Phoenix ICON, 100° FOV. Pediatric wide-field fundus photograph — 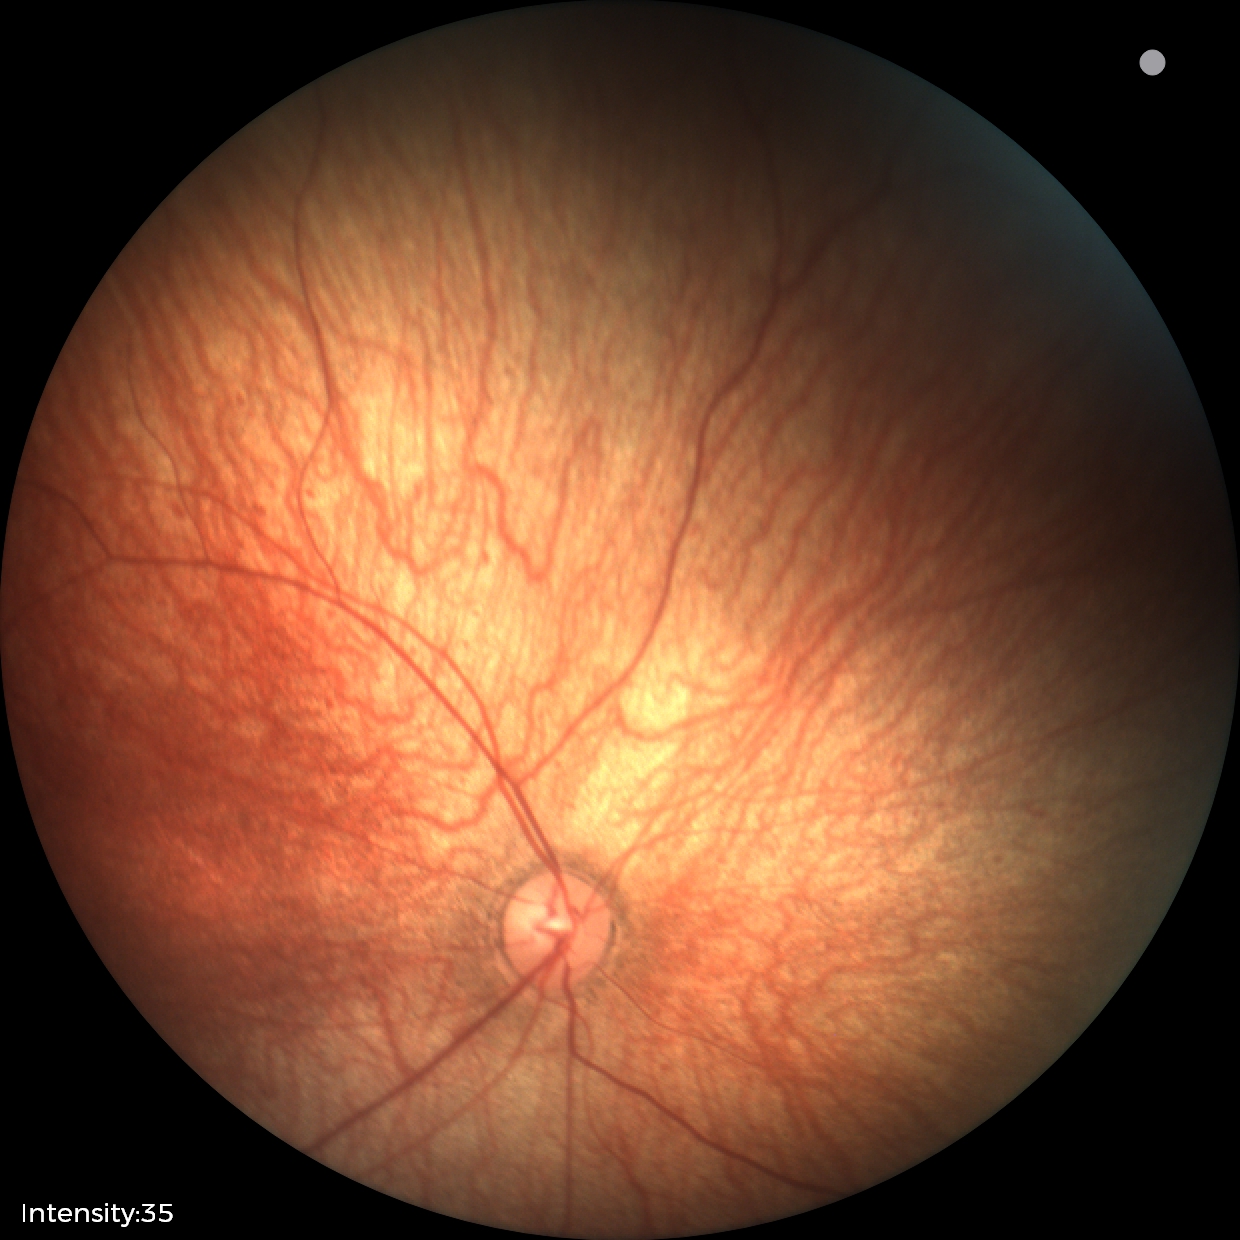

Normal screening examination.